Wide-field contact fundus photograph of an infant. Clarity RetCam 3, 130° FOV — 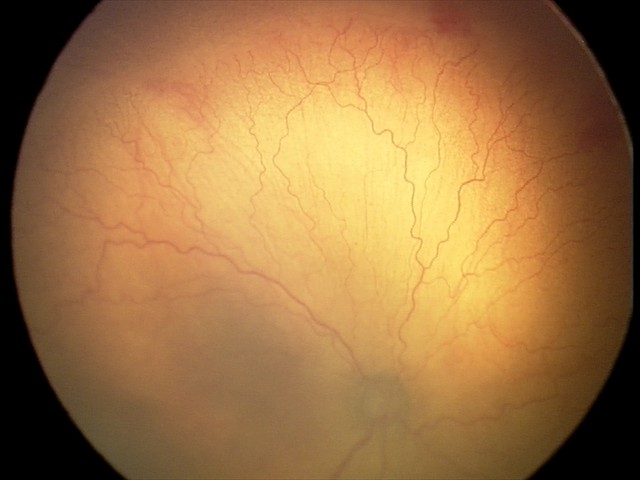 With plus disease. Screening series with aggressive retinopathy of prematurity — rapidly progressive severe ROP with prominent plus disease, often without classic stage progression.